Davis DR grading — 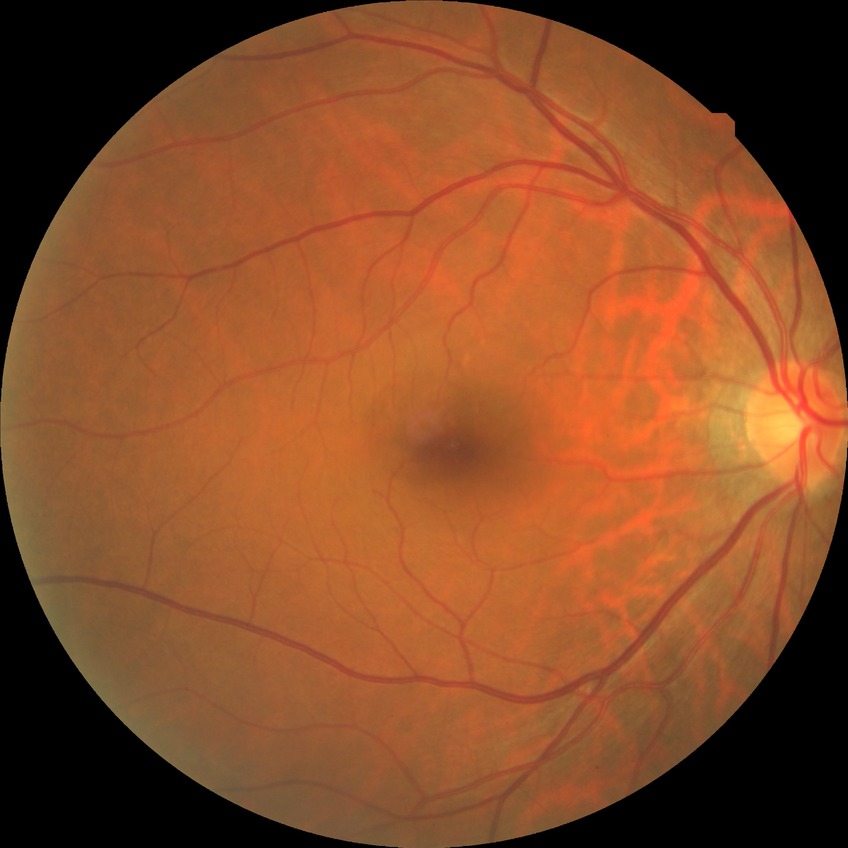

Diabetic retinopathy (DR): no diabetic retinopathy (NDR).